Diabetic retinopathy graded by the modified Davis classification: 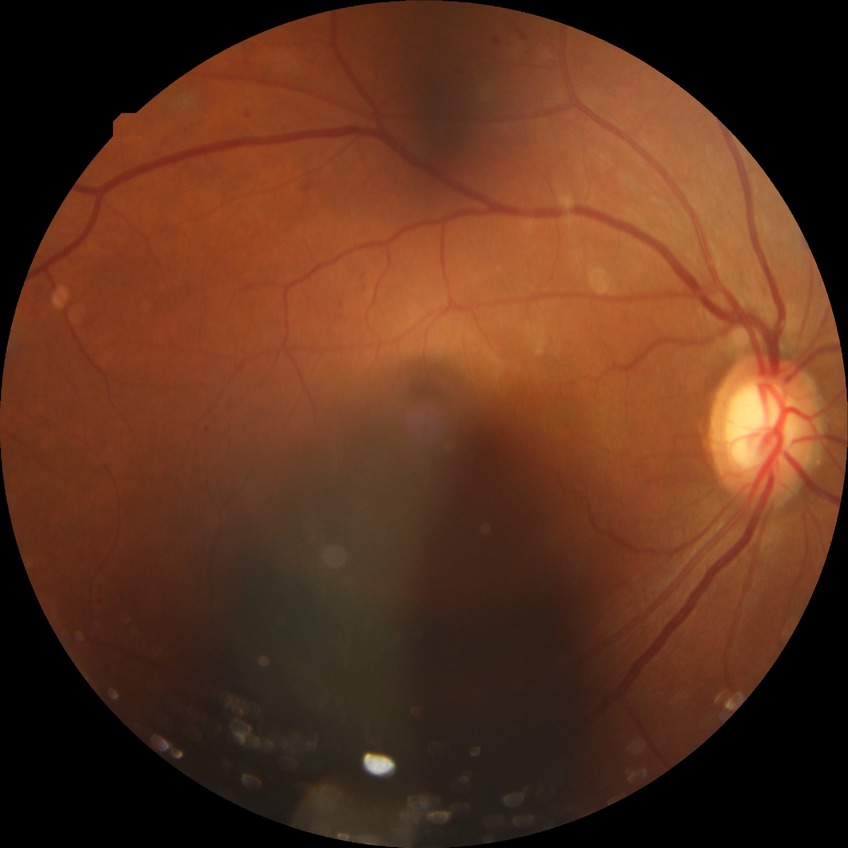
DR stage: PDR.